Non-mydriatic; fundus photo; centered on the optic disc
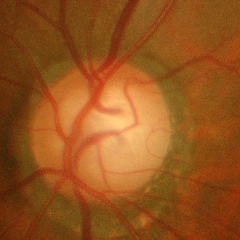

Advanced glaucoma.